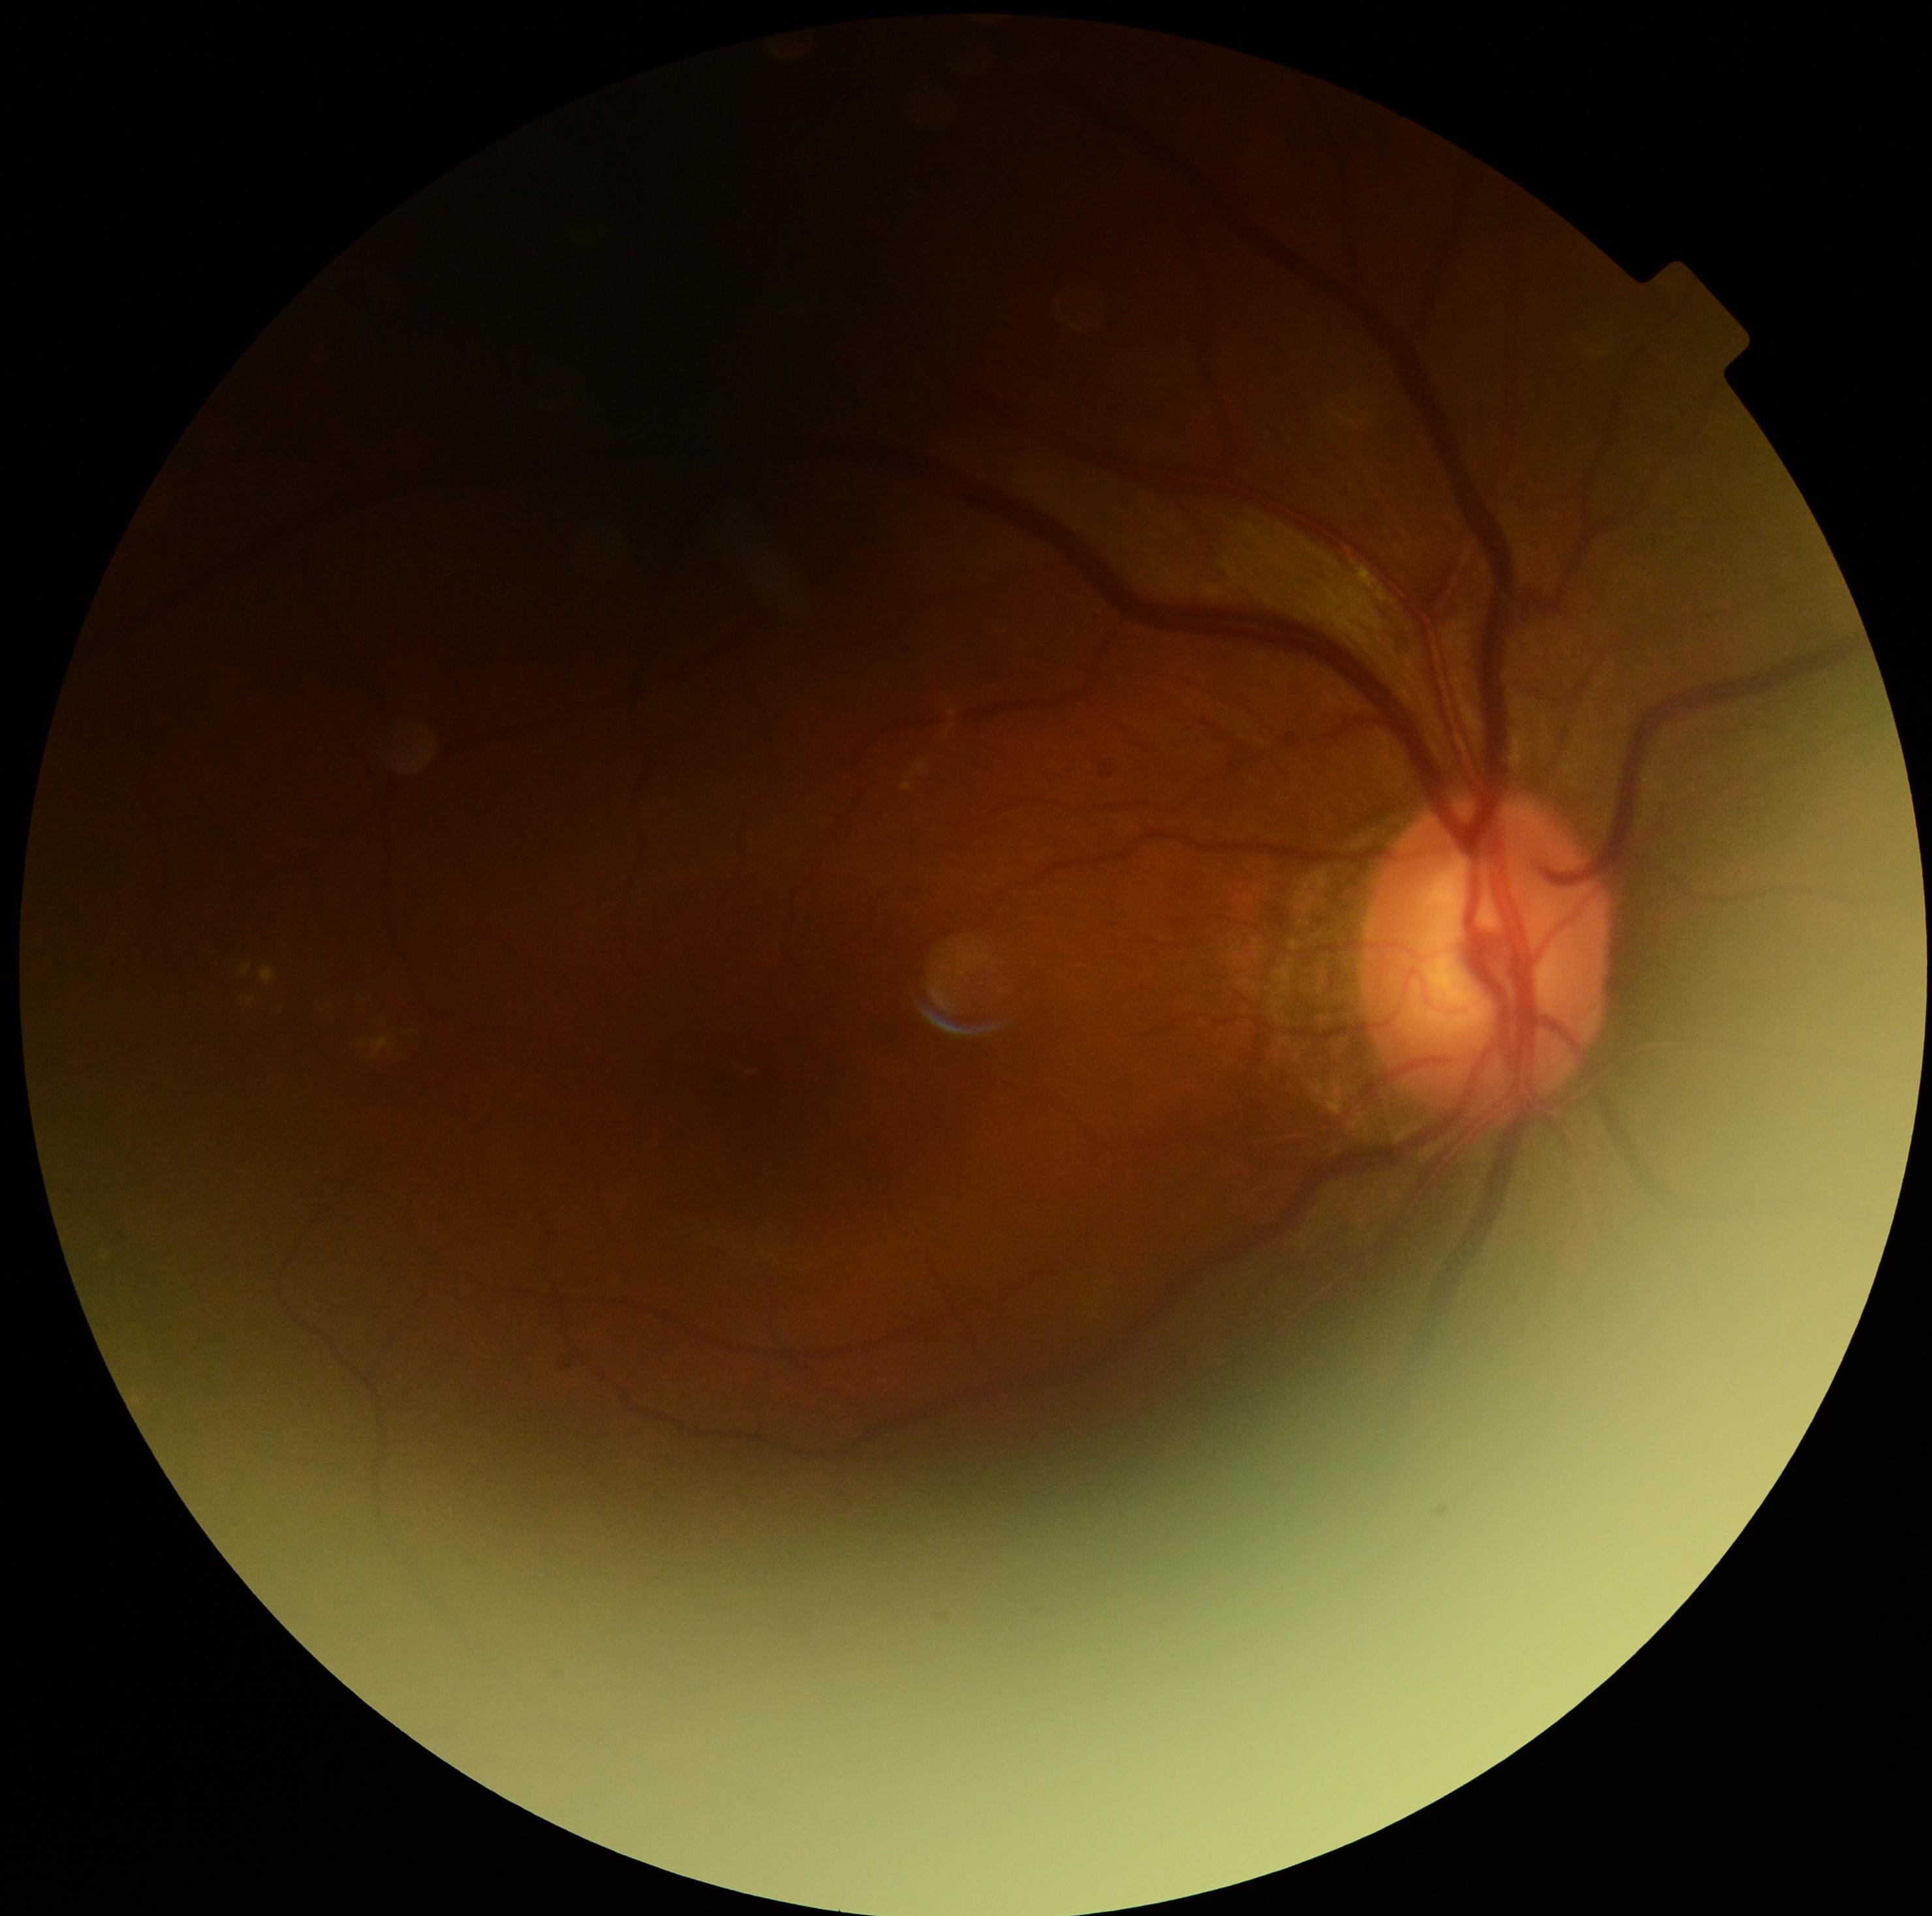

DR severity is moderate NPDR (grade 2).